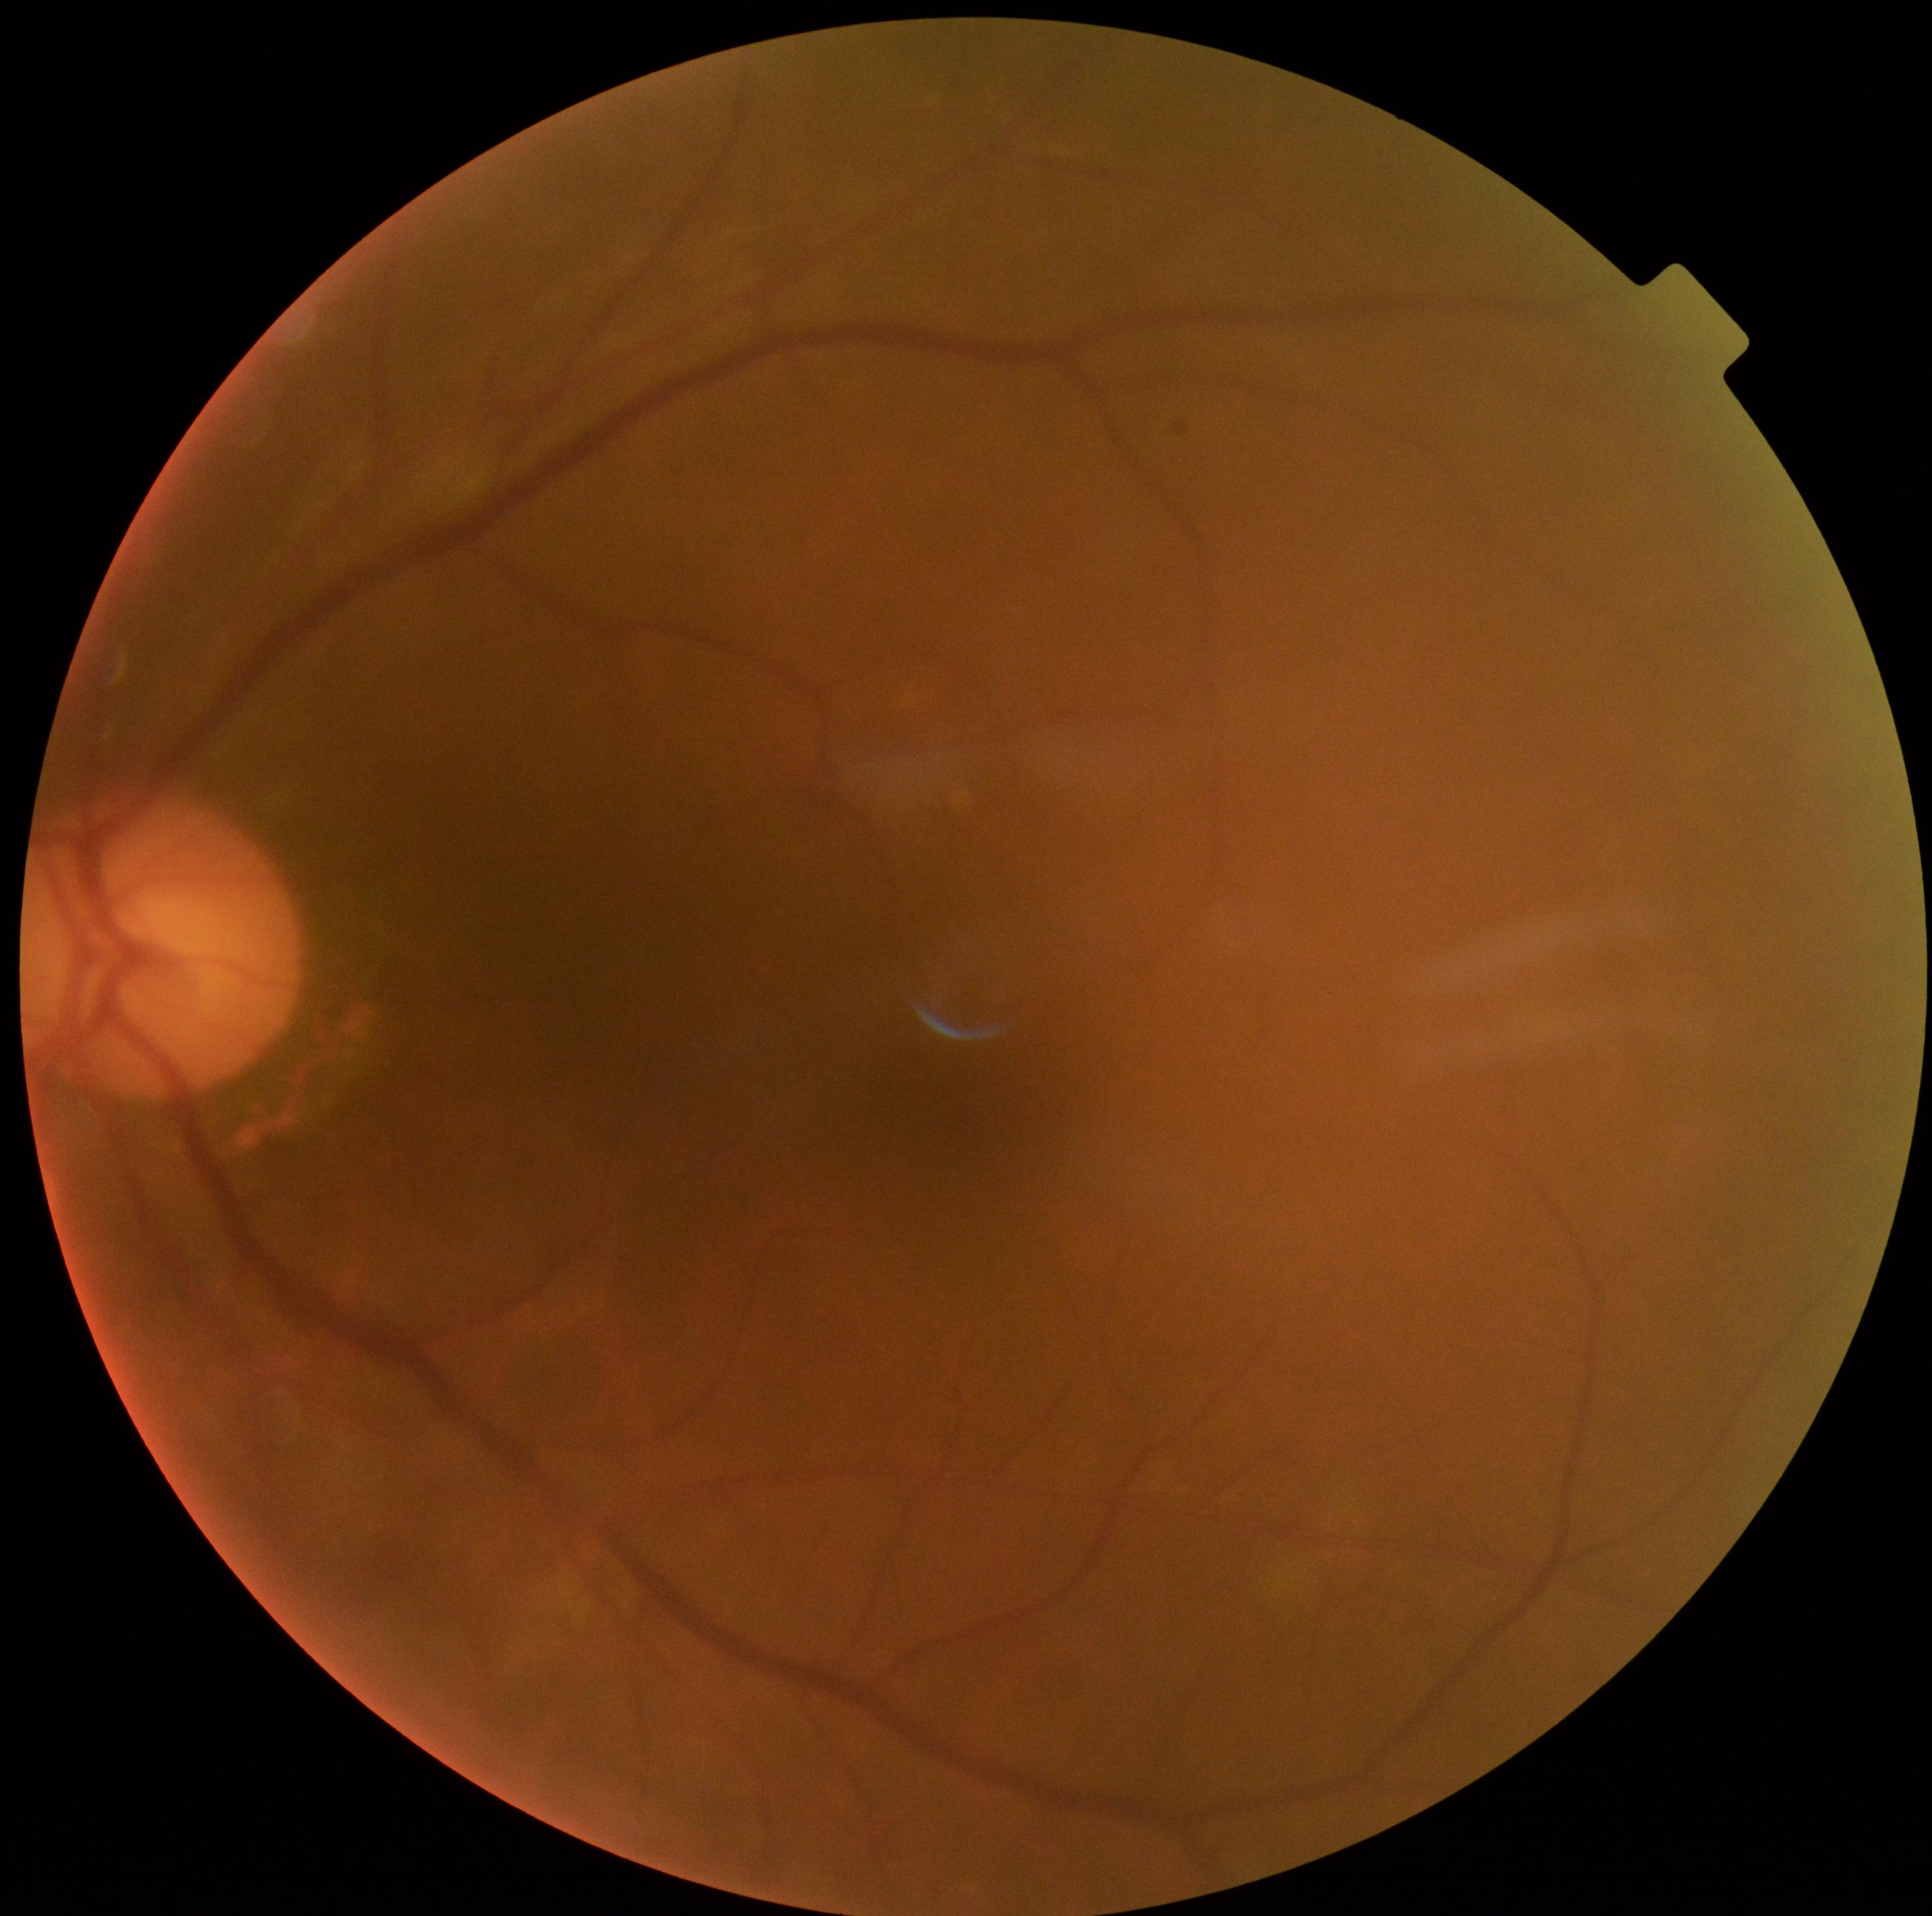

Diabetic retinopathy: grade 0 (no apparent retinopathy).